NIDEK AFC-230 fundus camera · 45 degree fundus photograph · nonmydriatic · posterior pole photograph:
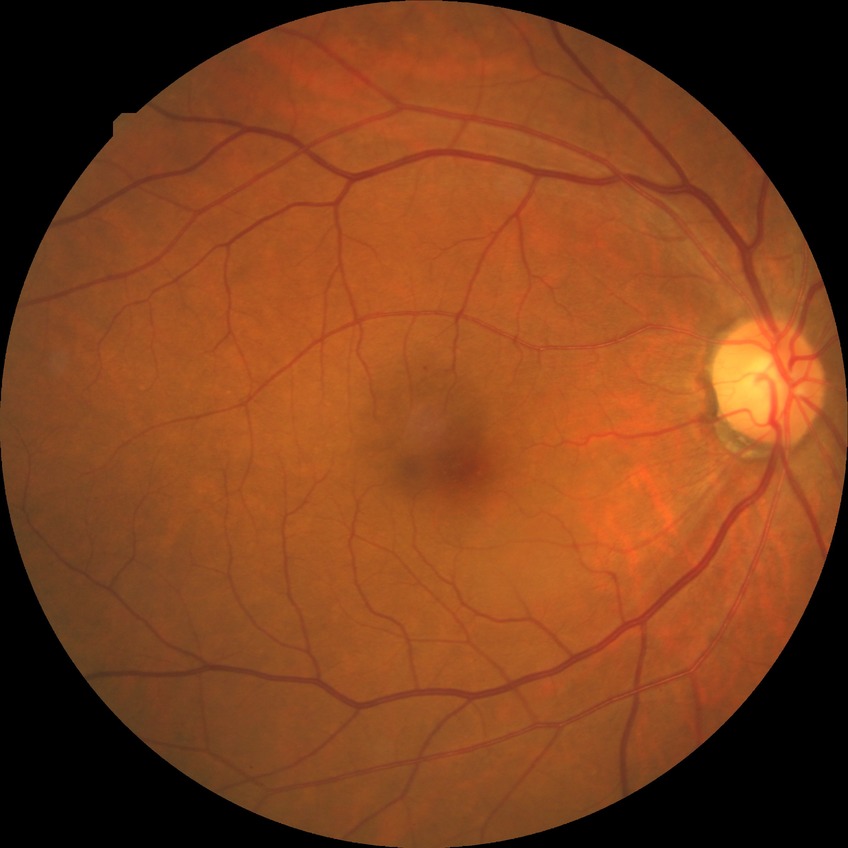

diabetic retinopathy severity = simple diabetic retinopathy.